Color fundus image:
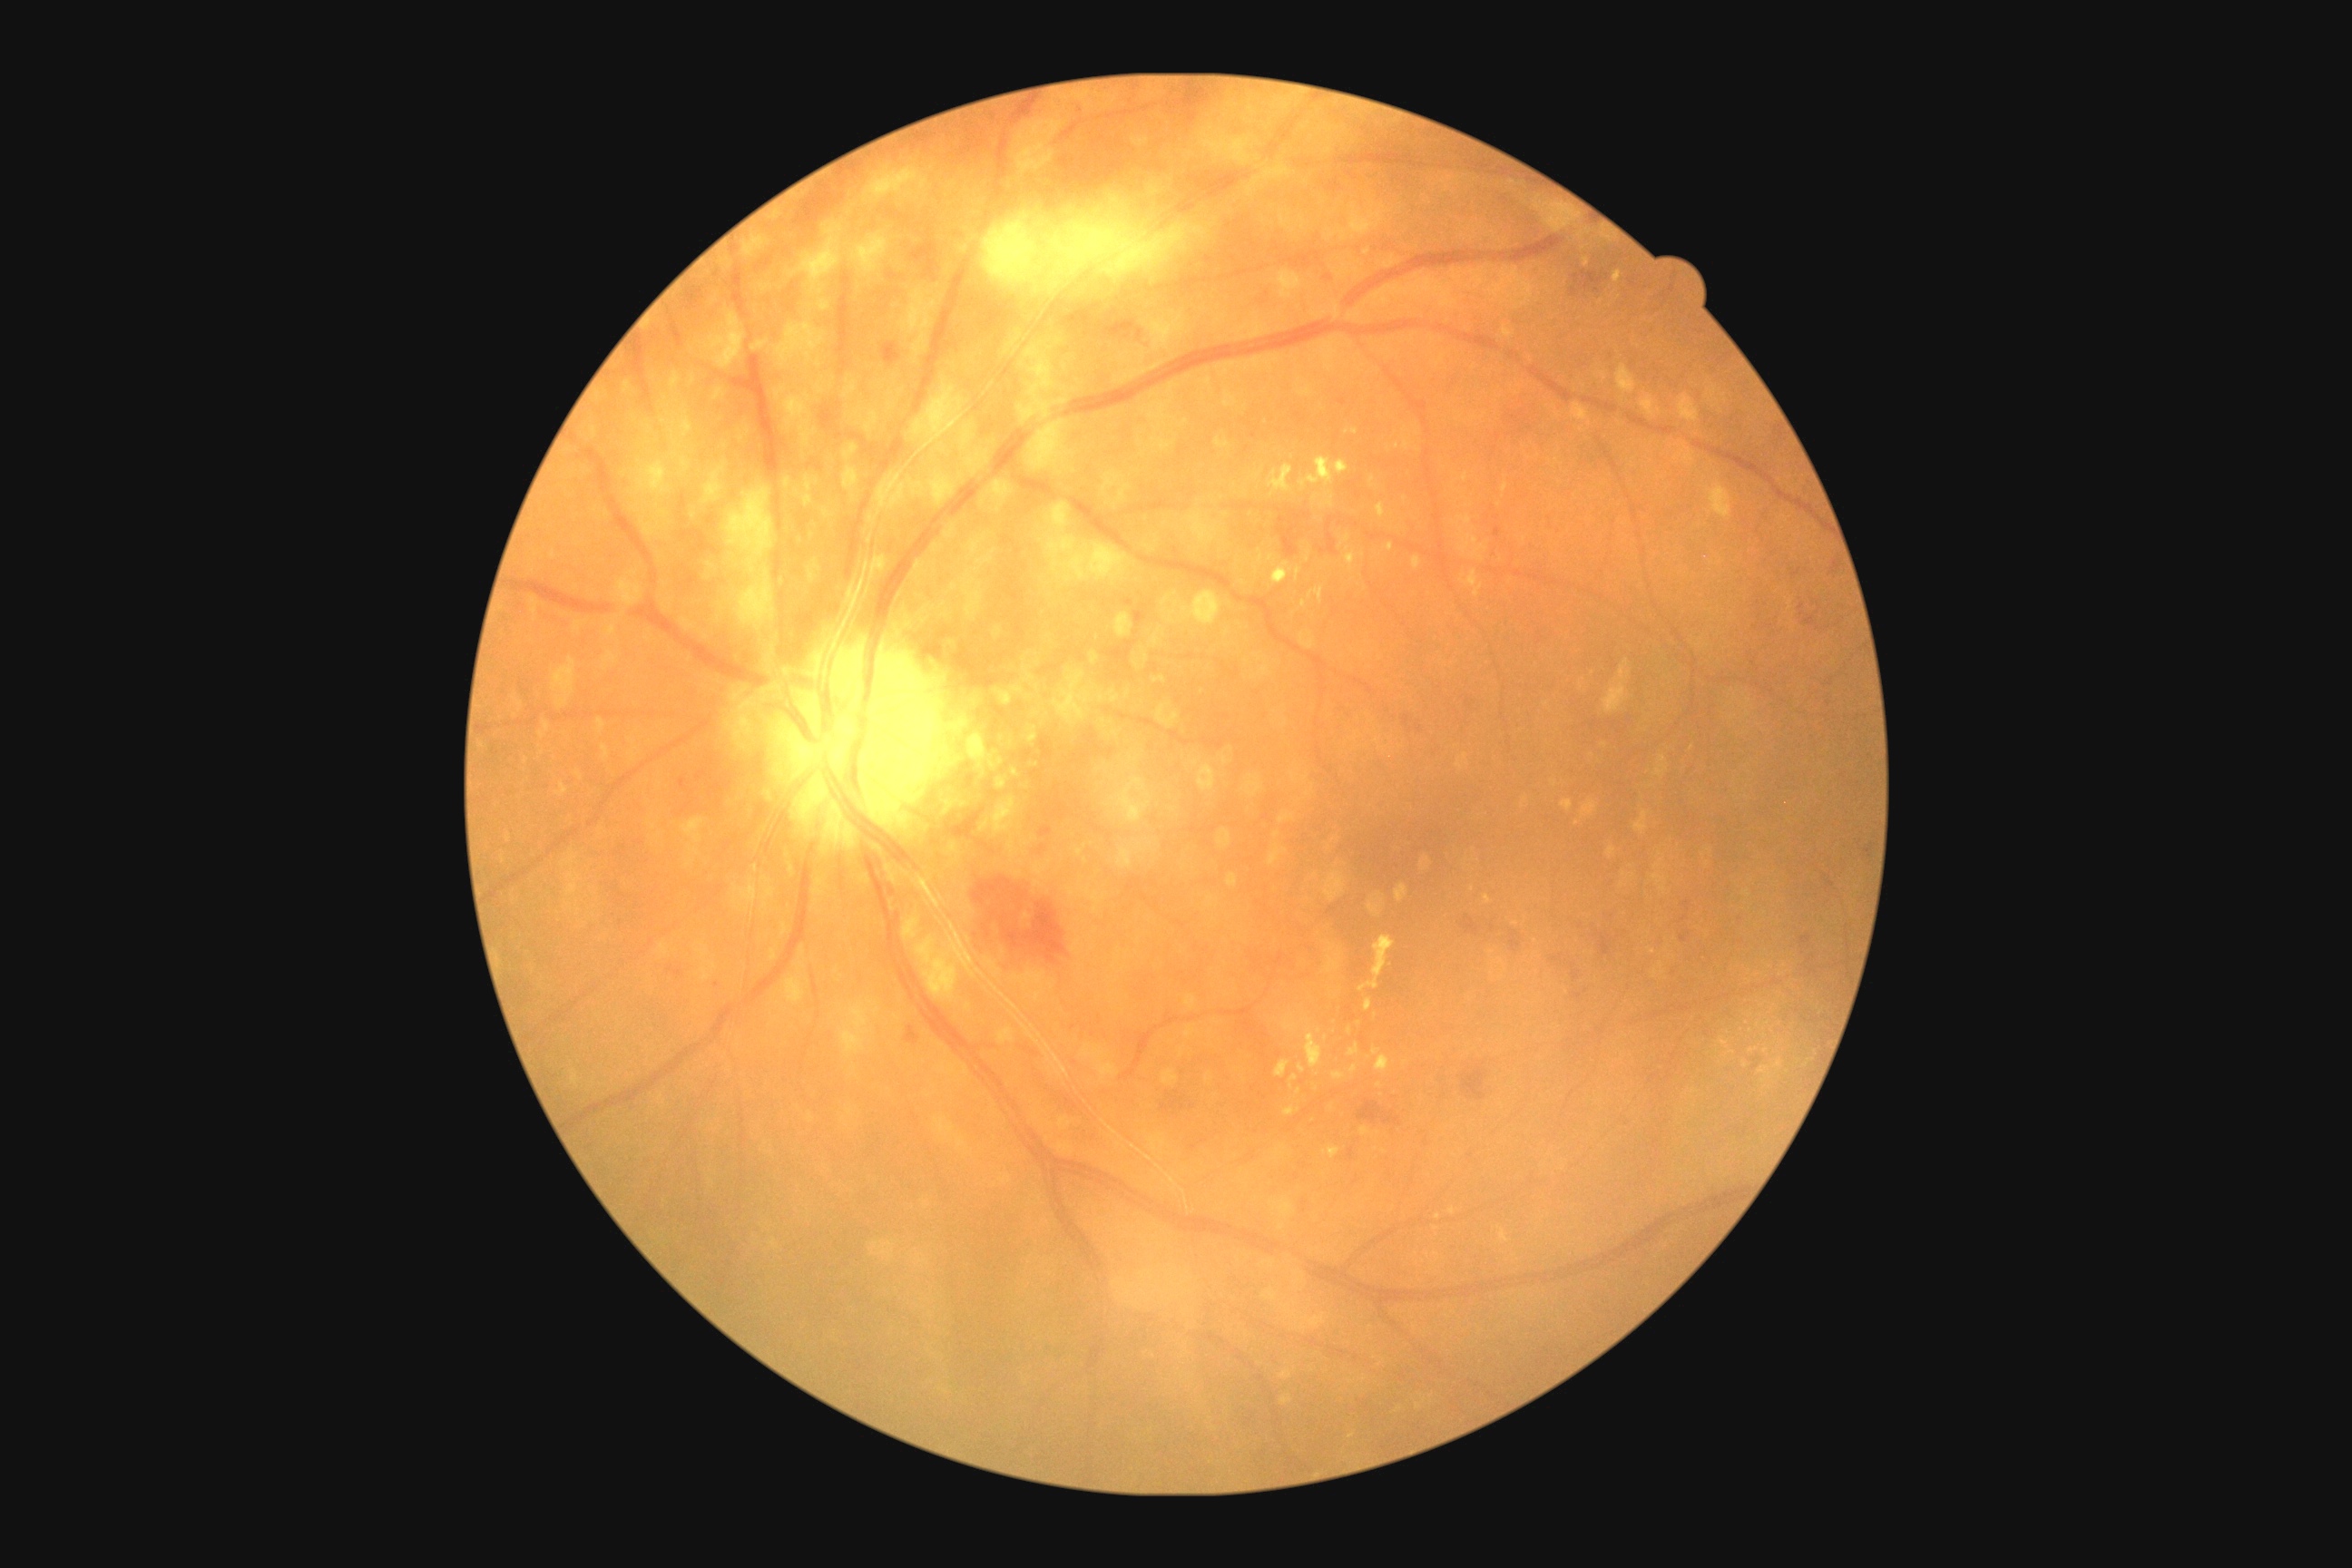
DR class: non-proliferative diabetic retinopathy, diabetic retinopathy: grade 2 (moderate NPDR).